DR severity per modified Davis staging
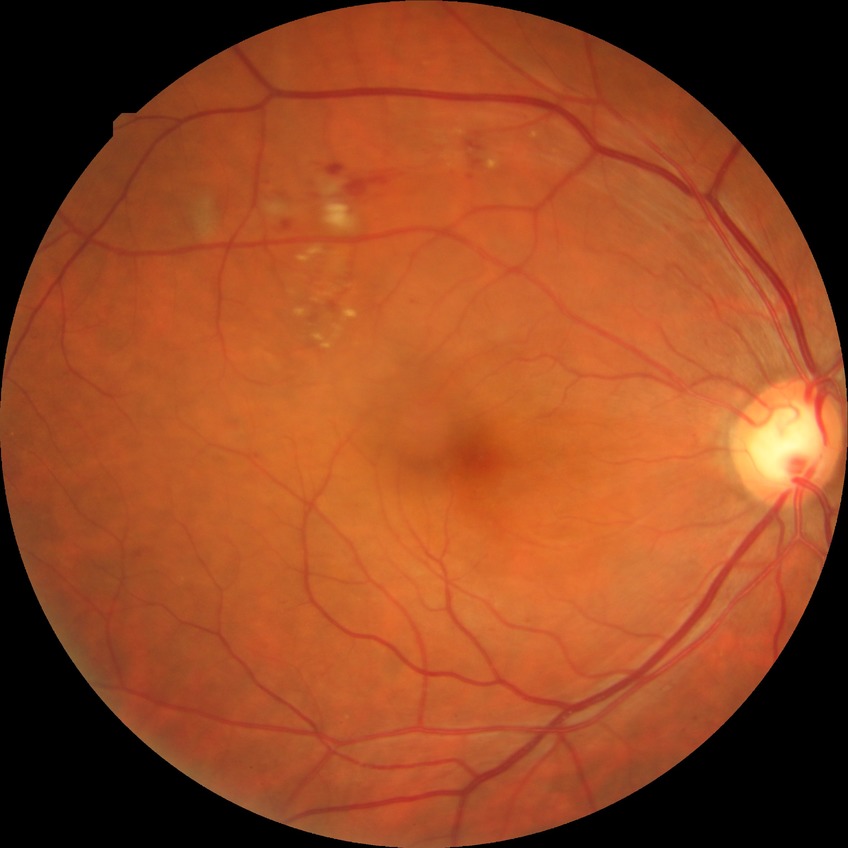
Diabetic retinopathy (DR): PPDR (pre-proliferative diabetic retinopathy).